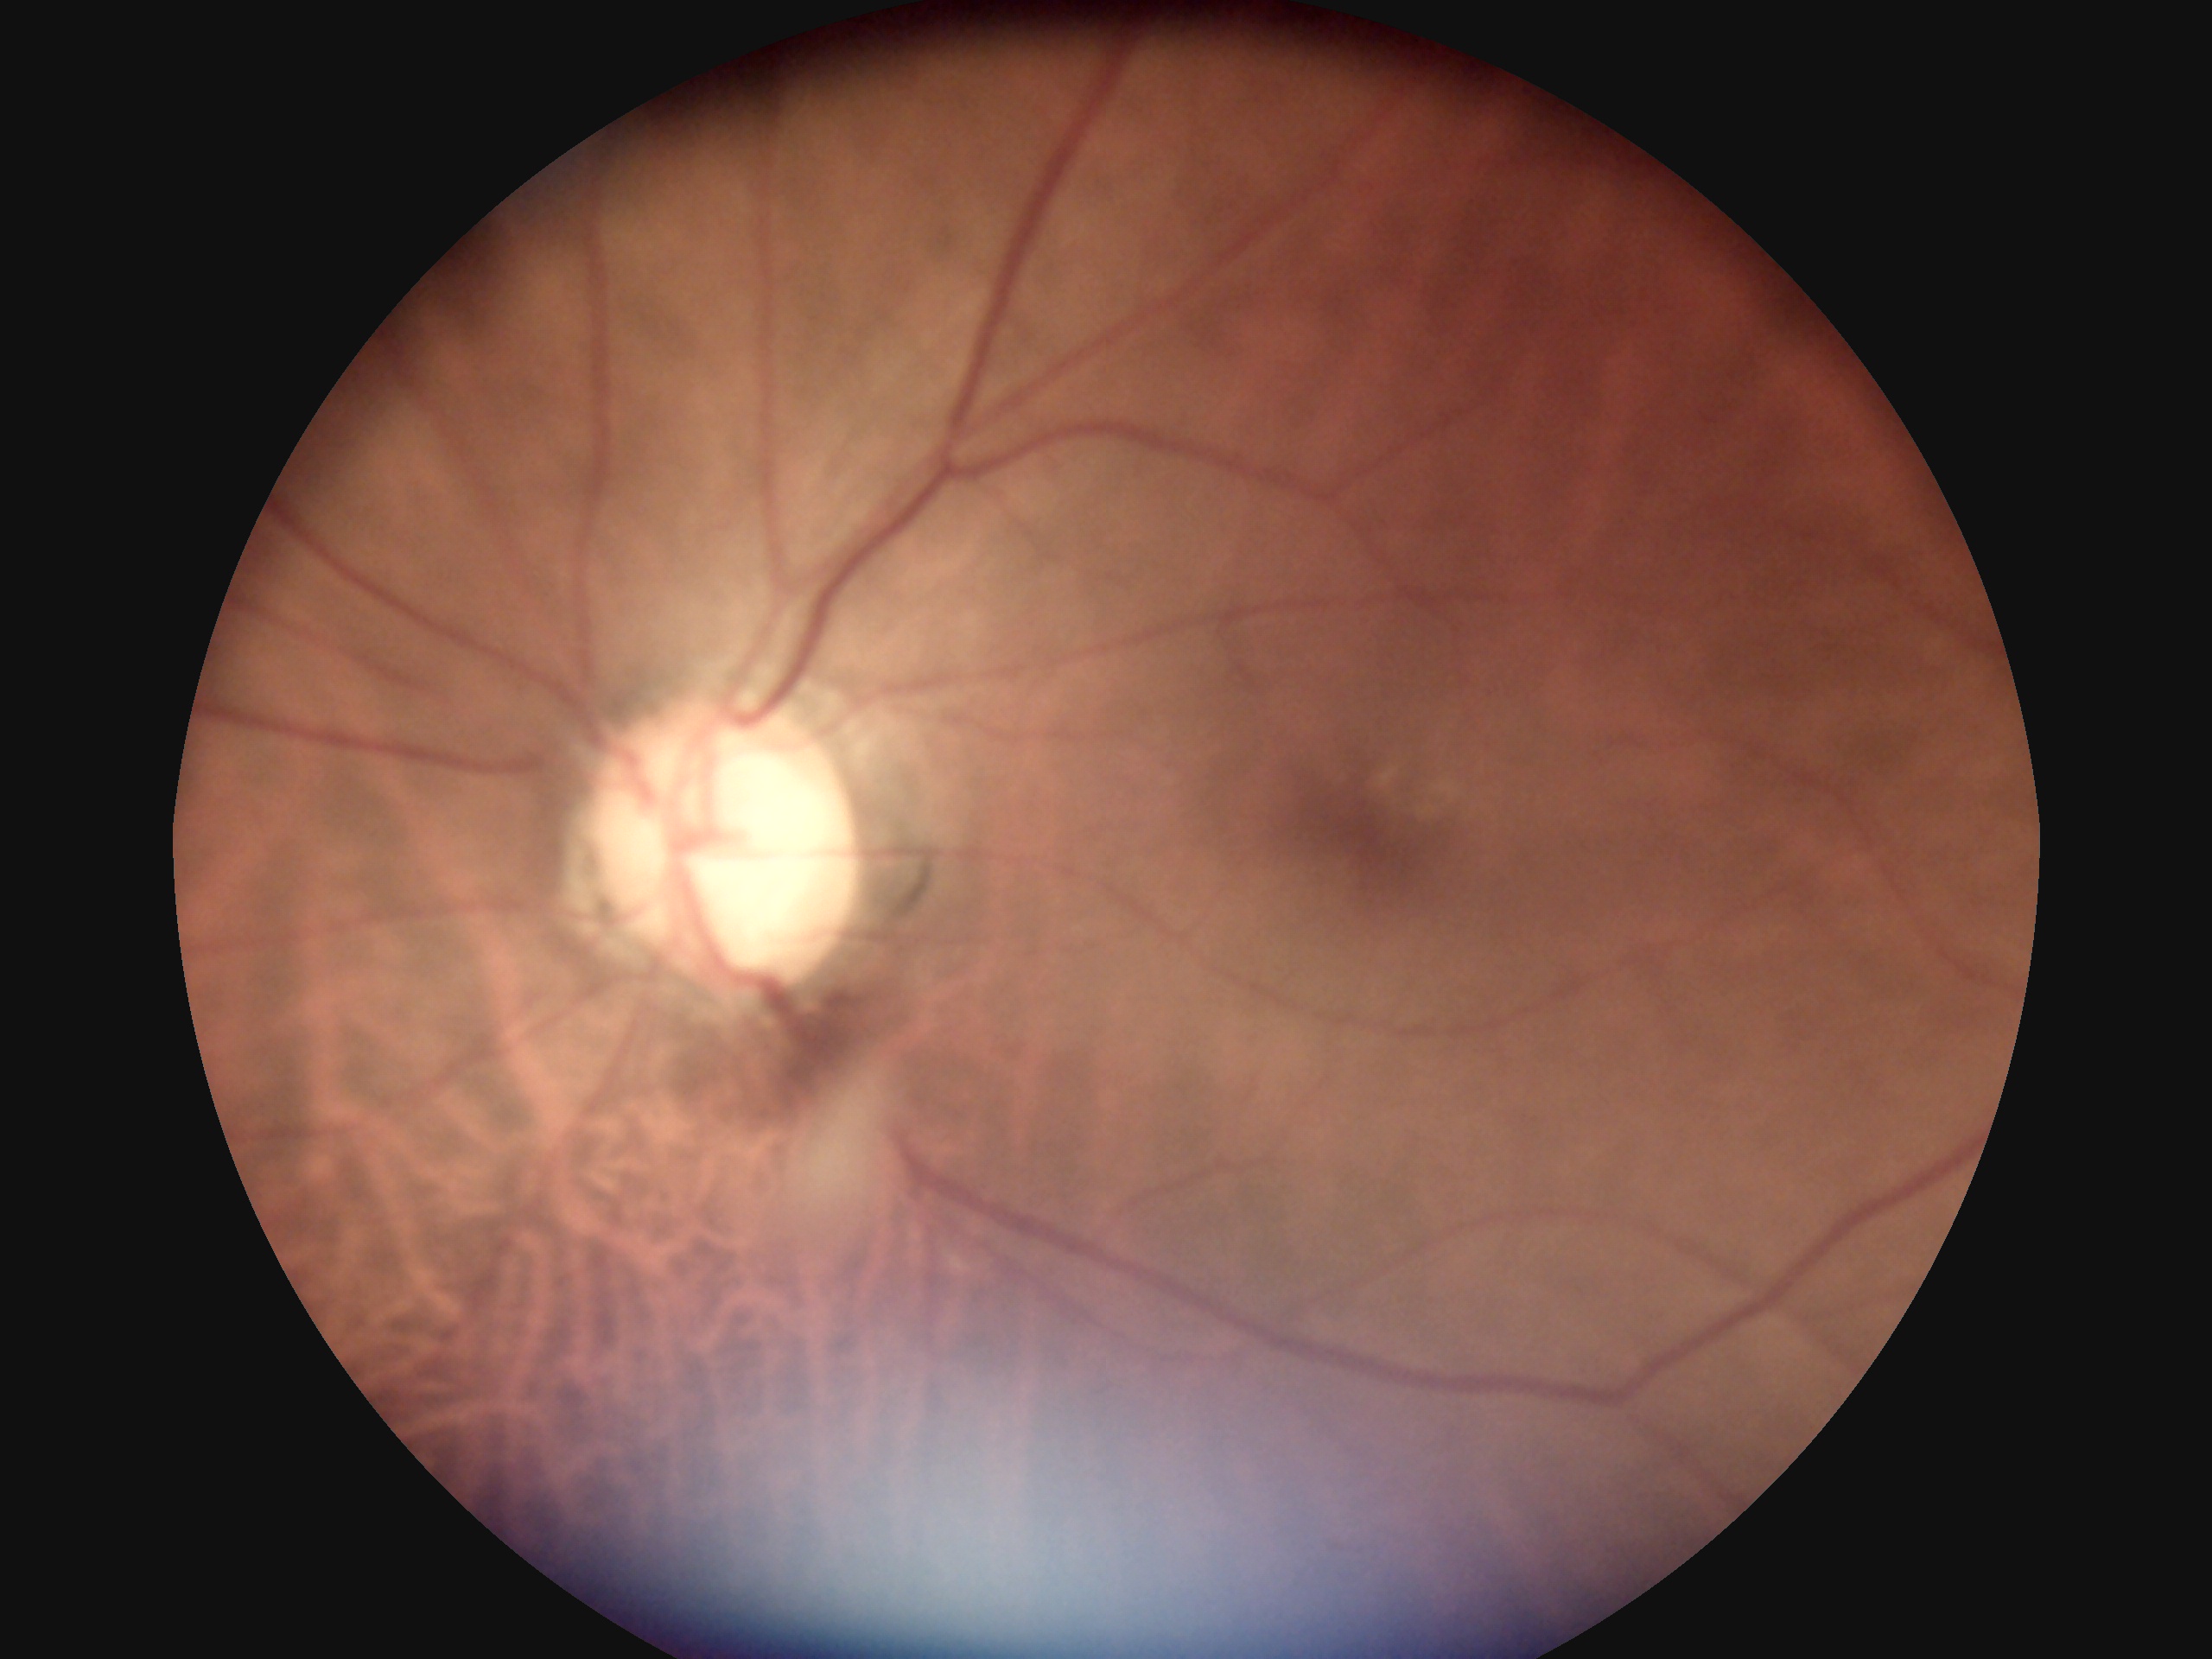

DR grade: 0 (no apparent retinopathy).